No pharmacologic dilation
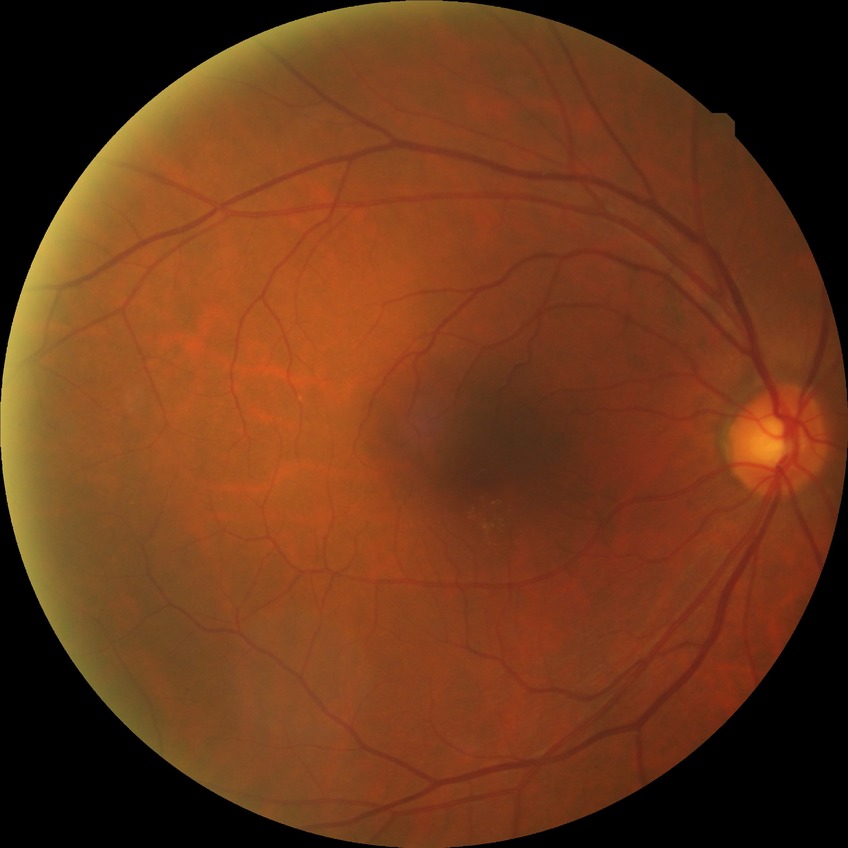

Diabetic retinopathy (DR) is no diabetic retinopathy (NDR).